Optic nerve head photograph; 742 x 742 pixels — 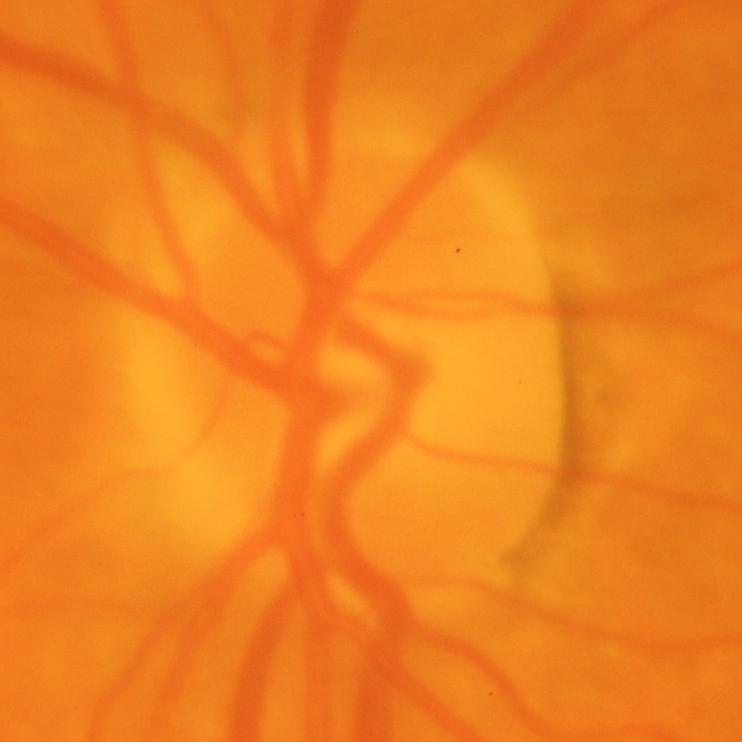
Glaucoma.